848x848px. Retinal fundus photograph
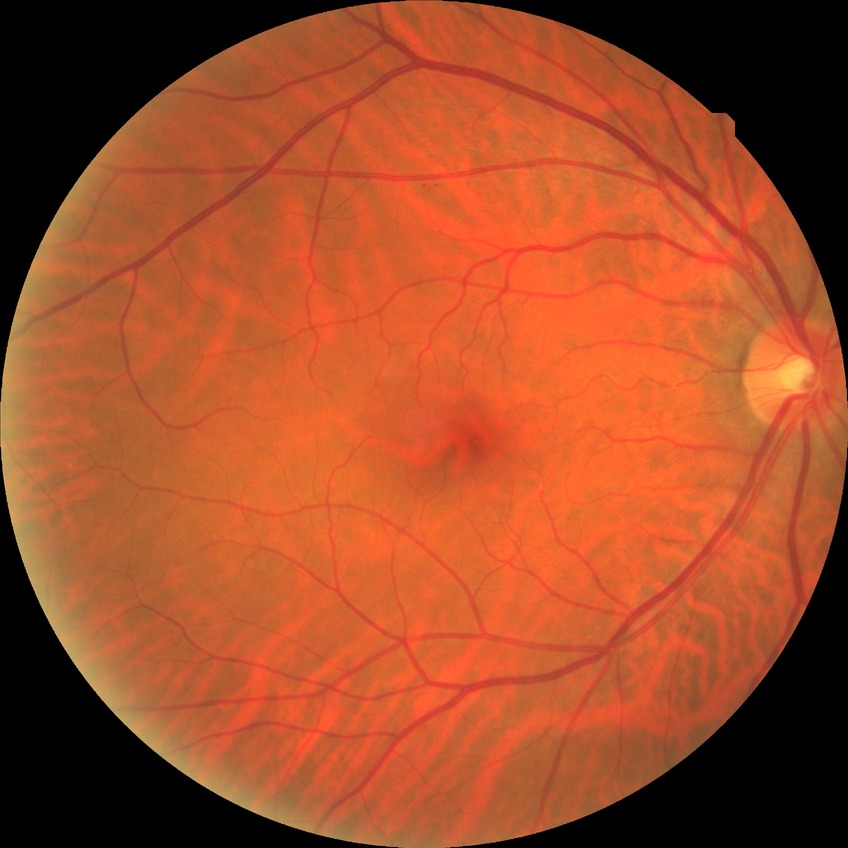

Davis DR grade: NDR.